DR severity per modified Davis staging — 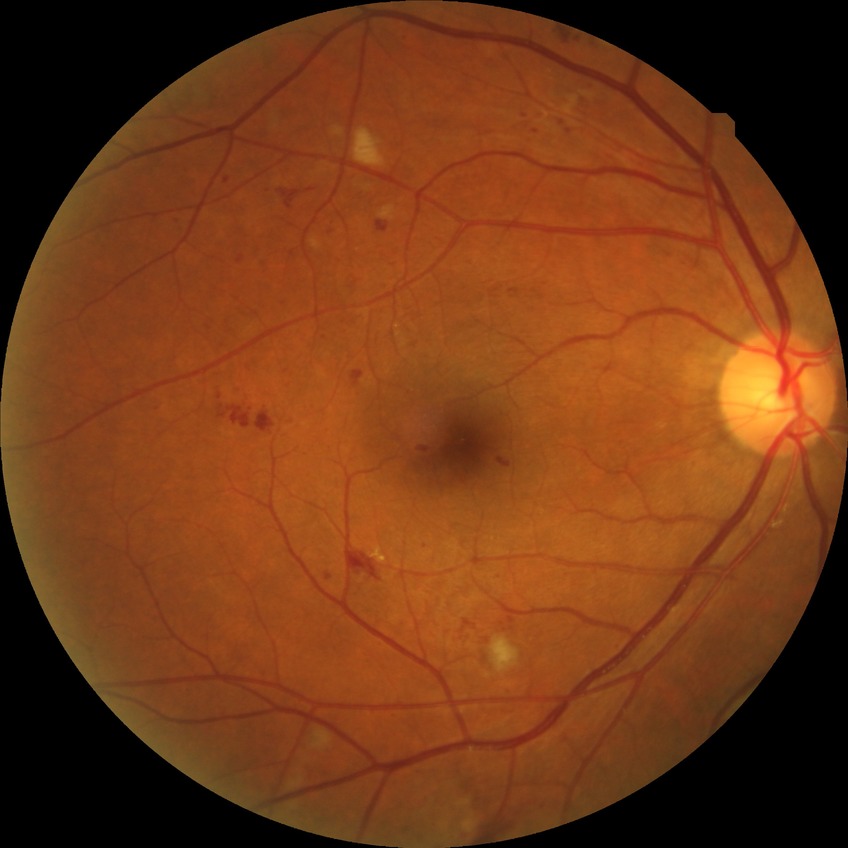   davis_grade: SDR